Fundus photo. 45° FOV. 1536x1152px — 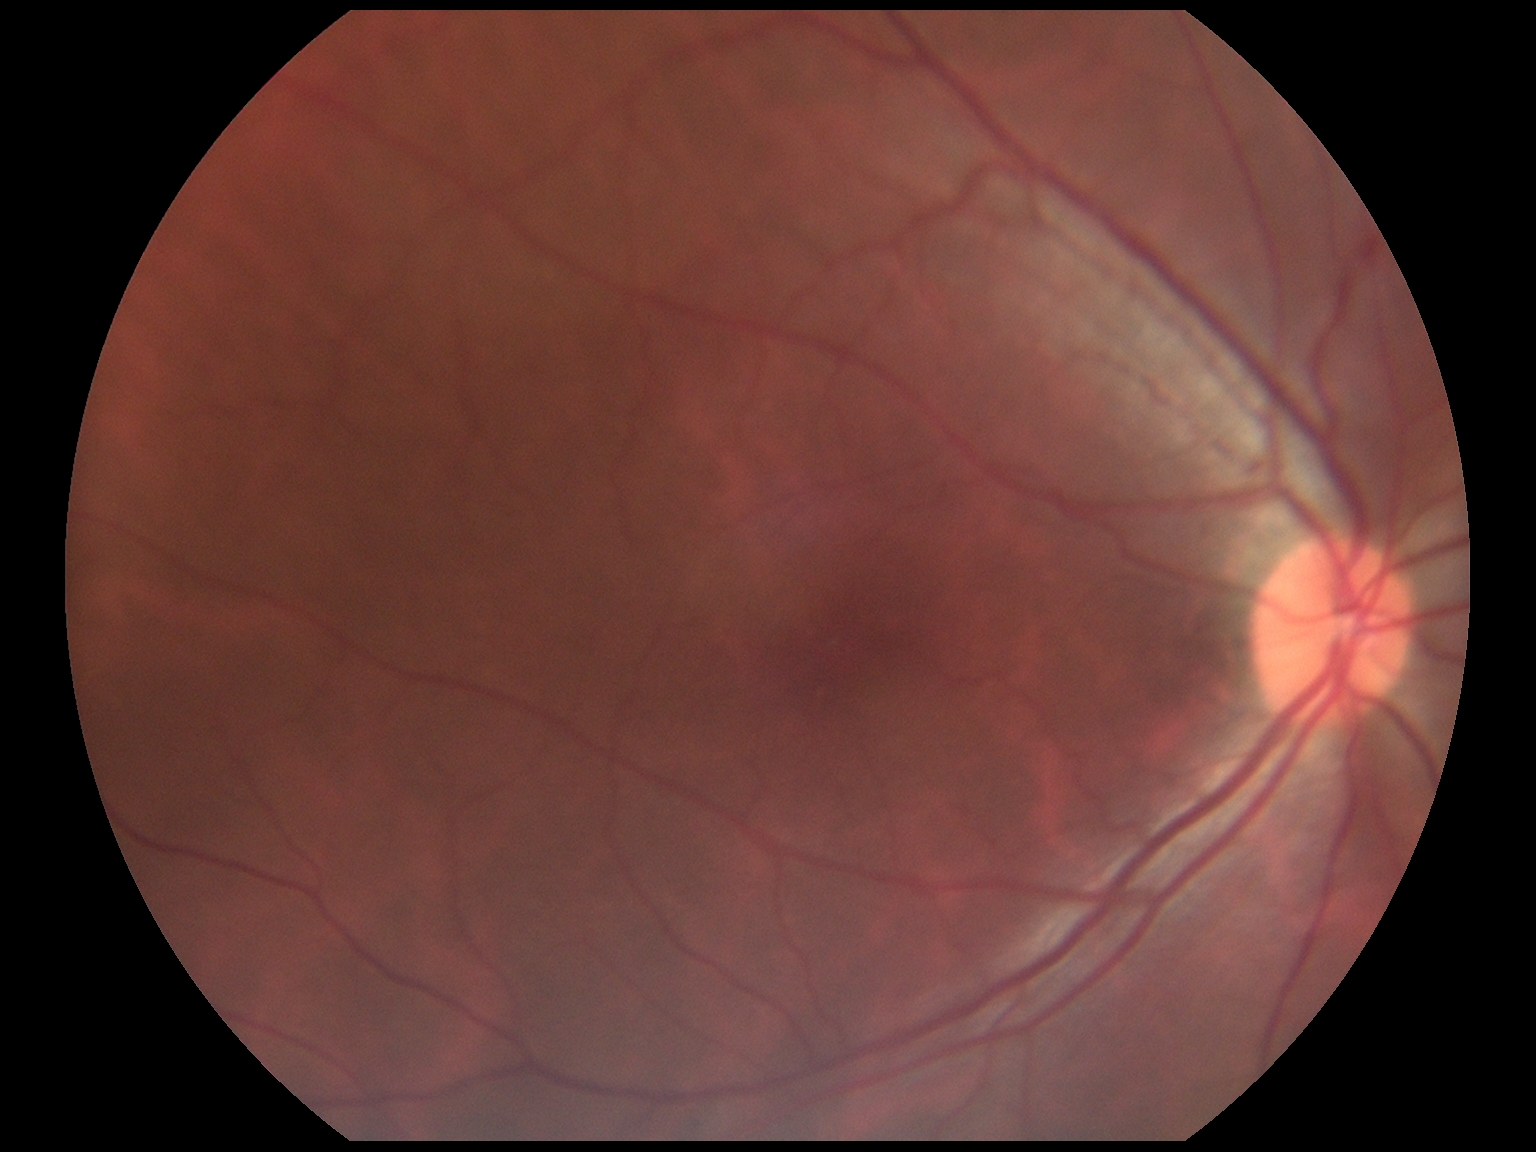

No apparent diabetic retinopathy.
Diabetic retinopathy grade is no apparent retinopathy (0).